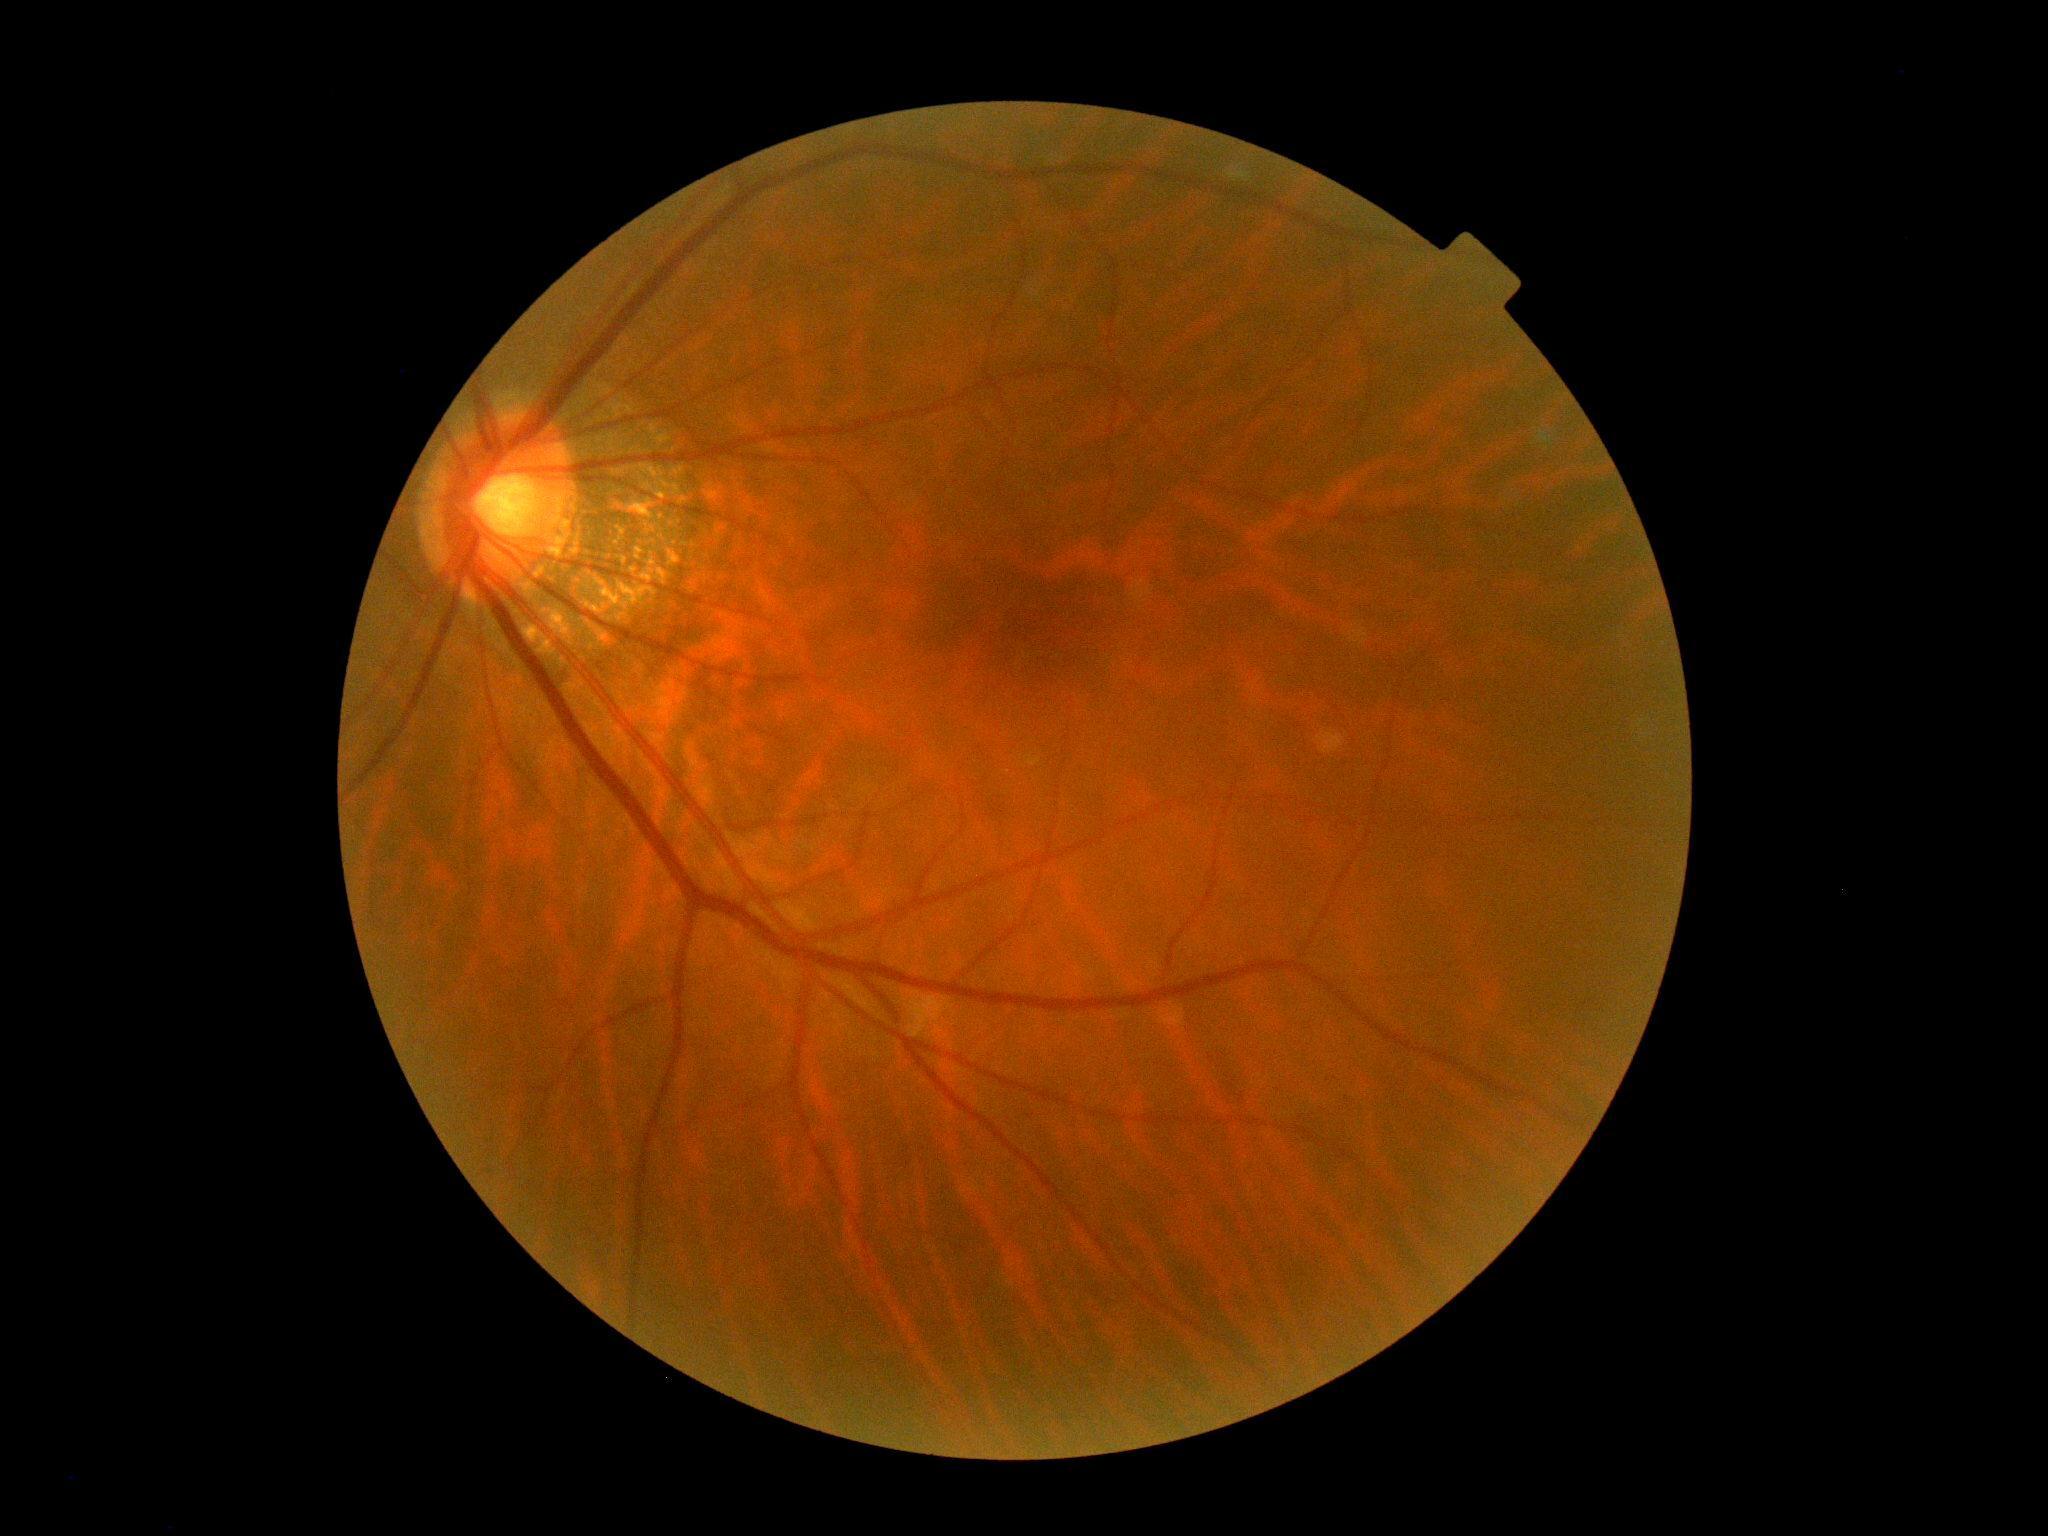
DR stage: grade 0 (no apparent retinopathy).